CFP:
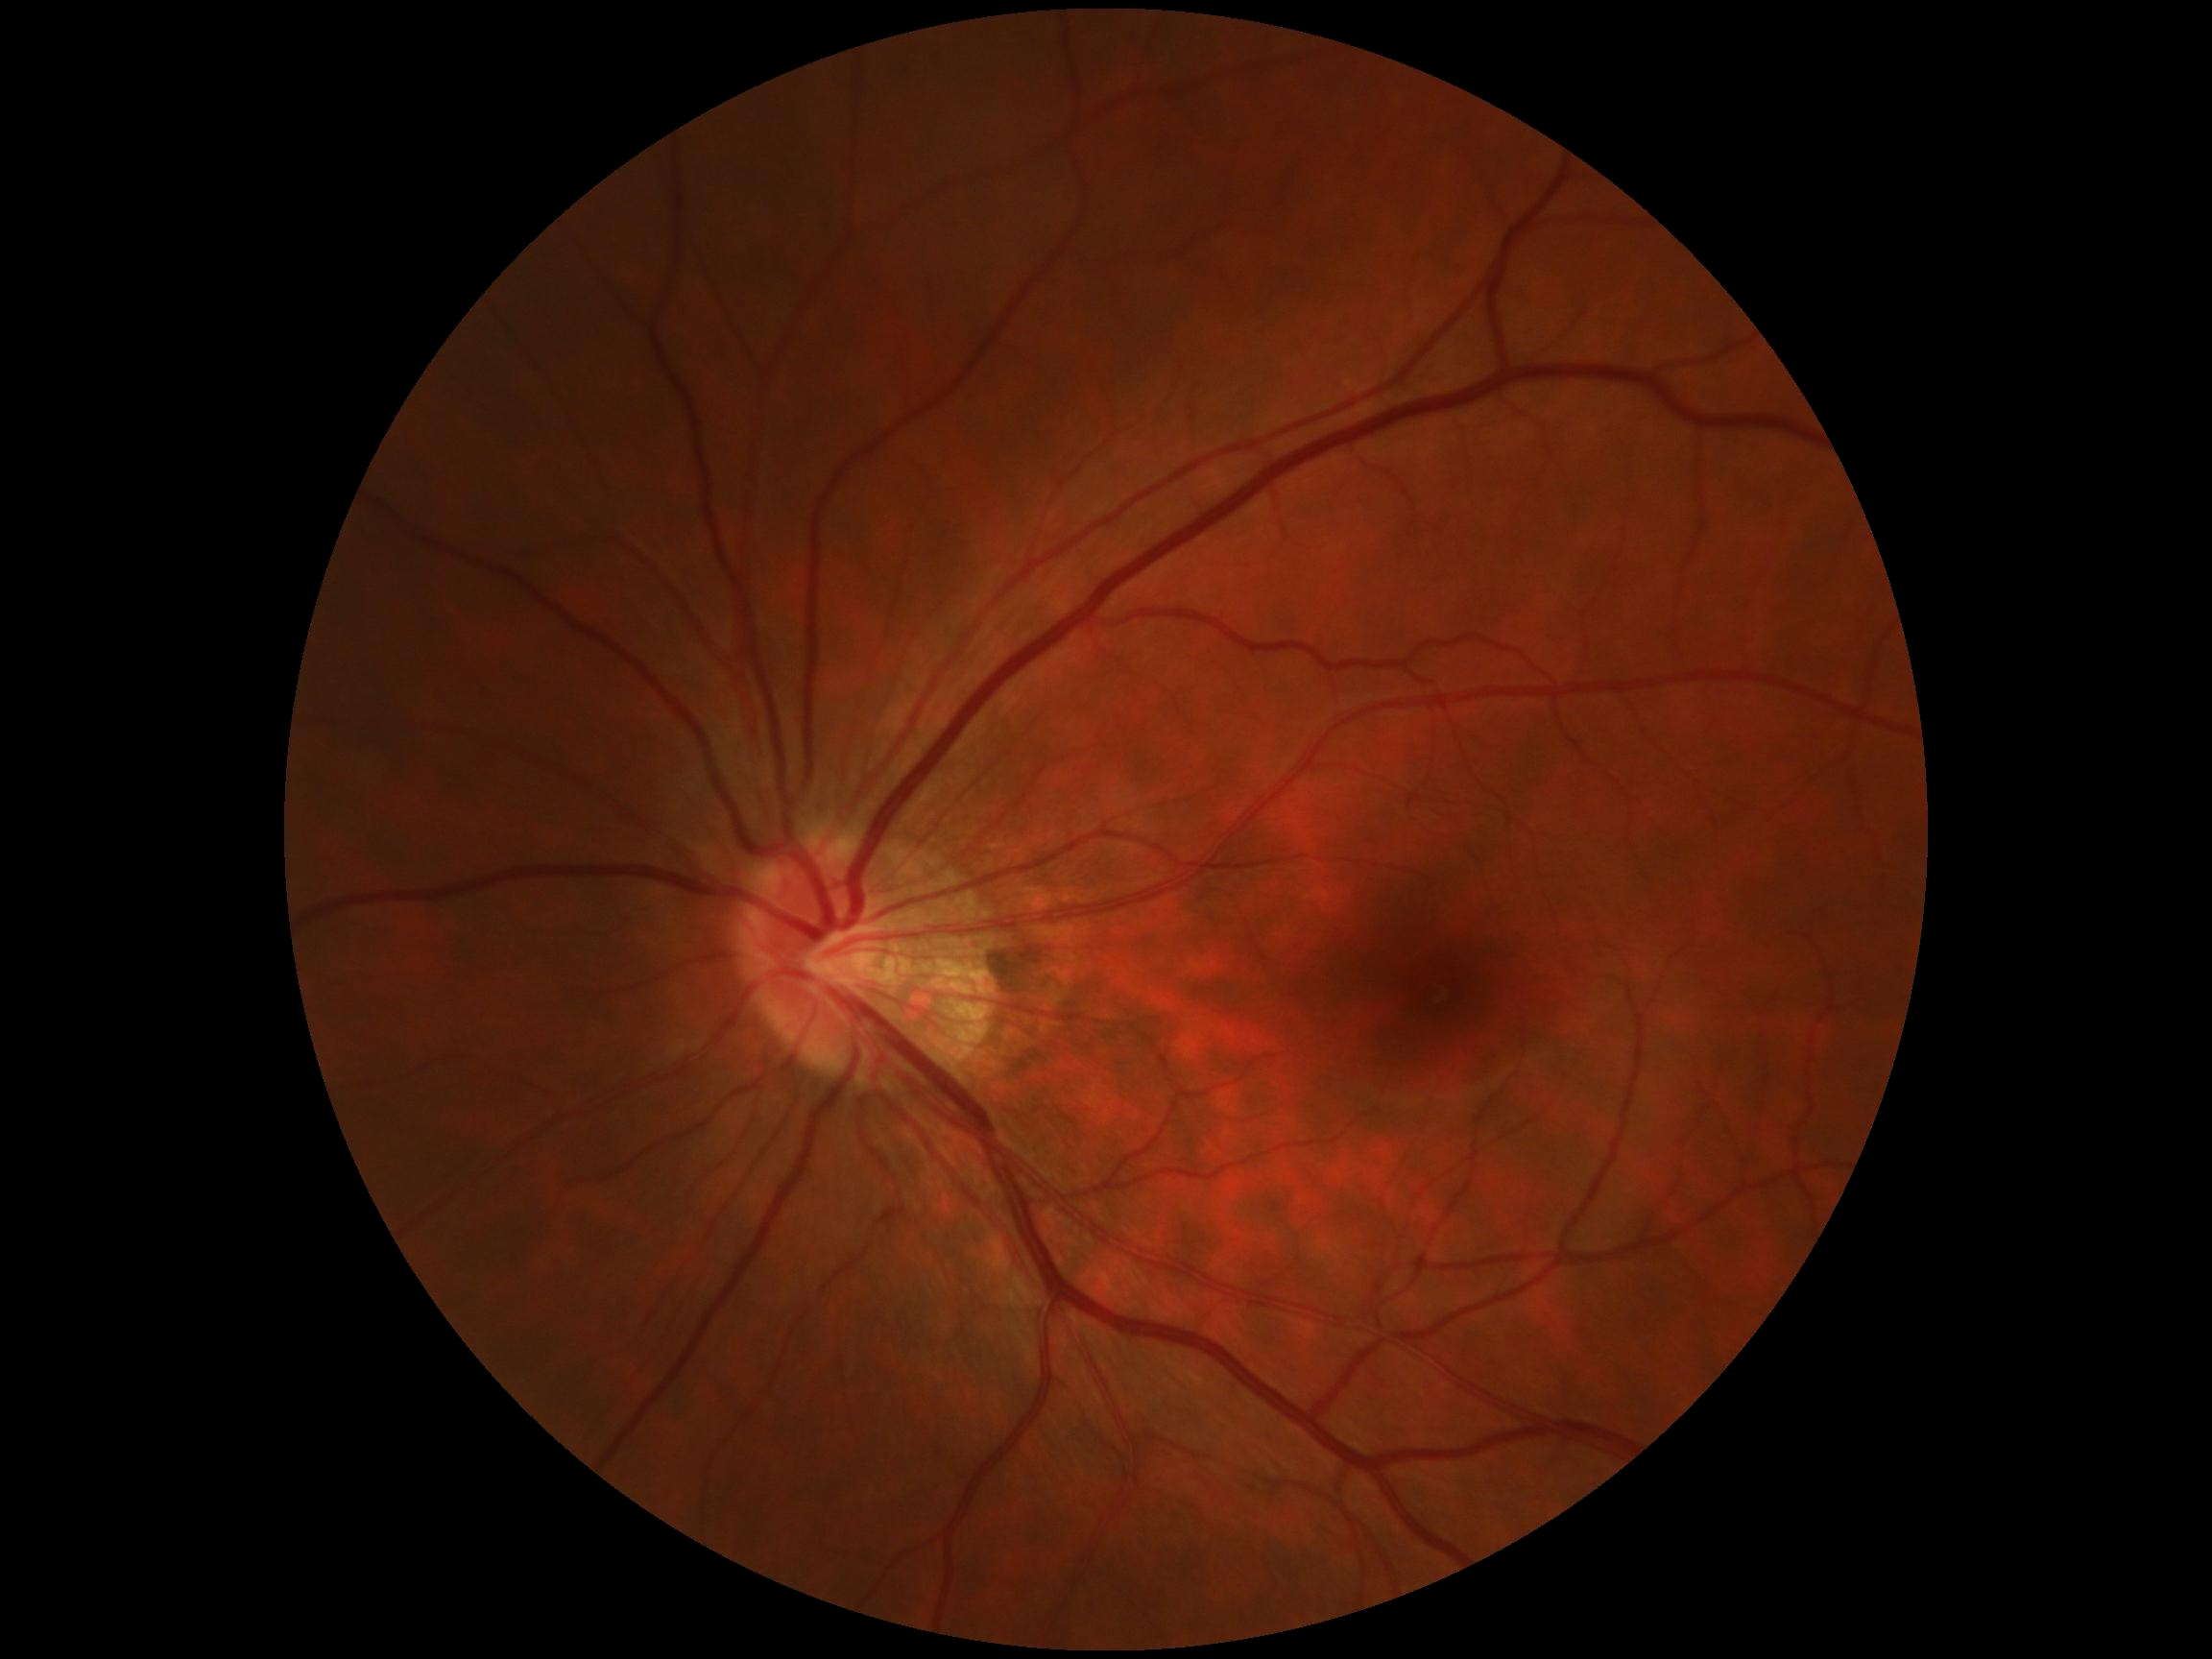

DR impression = negative for DR | DR grade = 0.